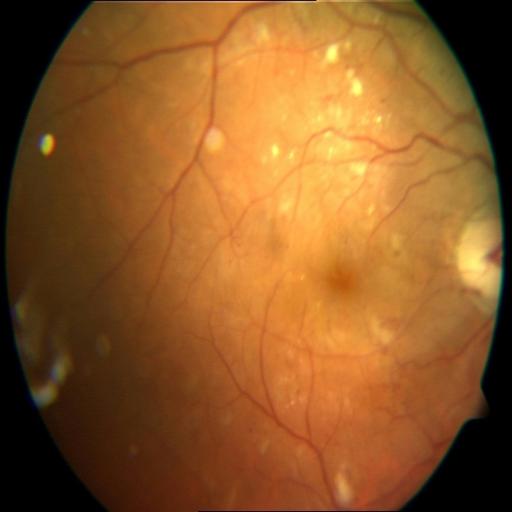

Pathology:
- cotton wool spots